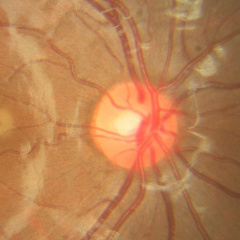
Glaucoma diagnosis: no glaucomatous changes.